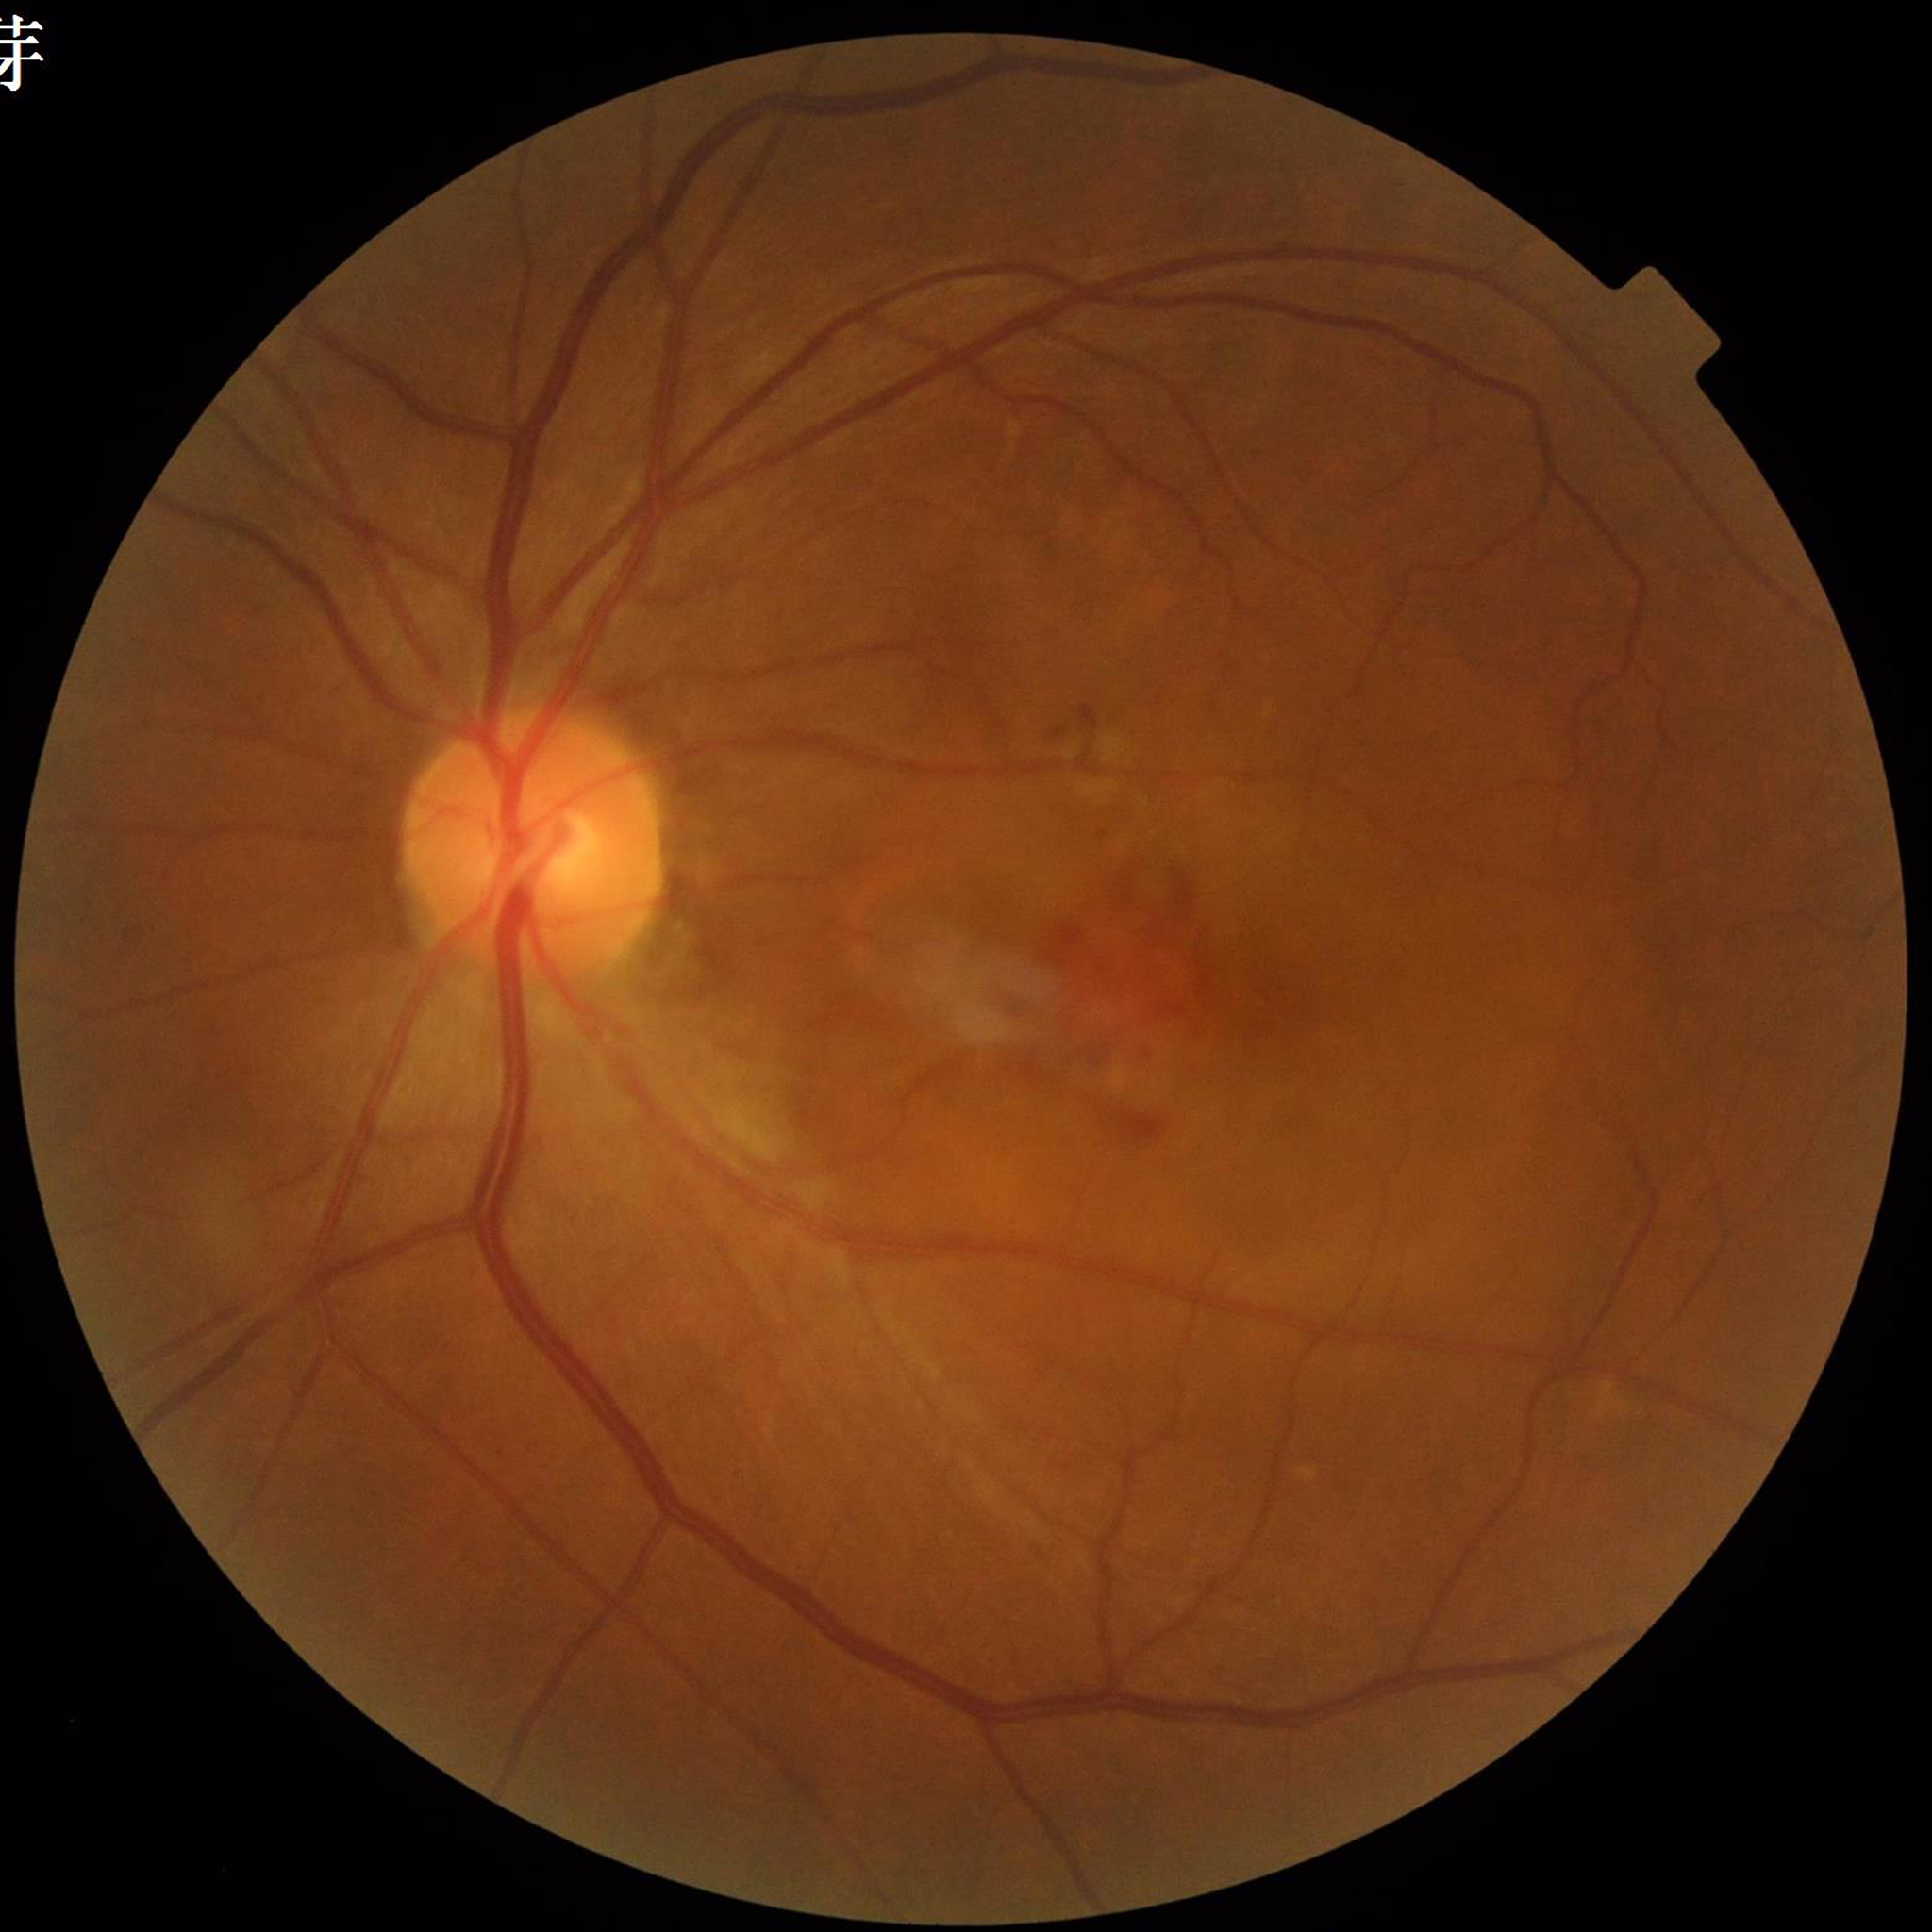
Quality assessment: adequate.
Diagnosed with age-related macular degeneration (AMD).